CFP: 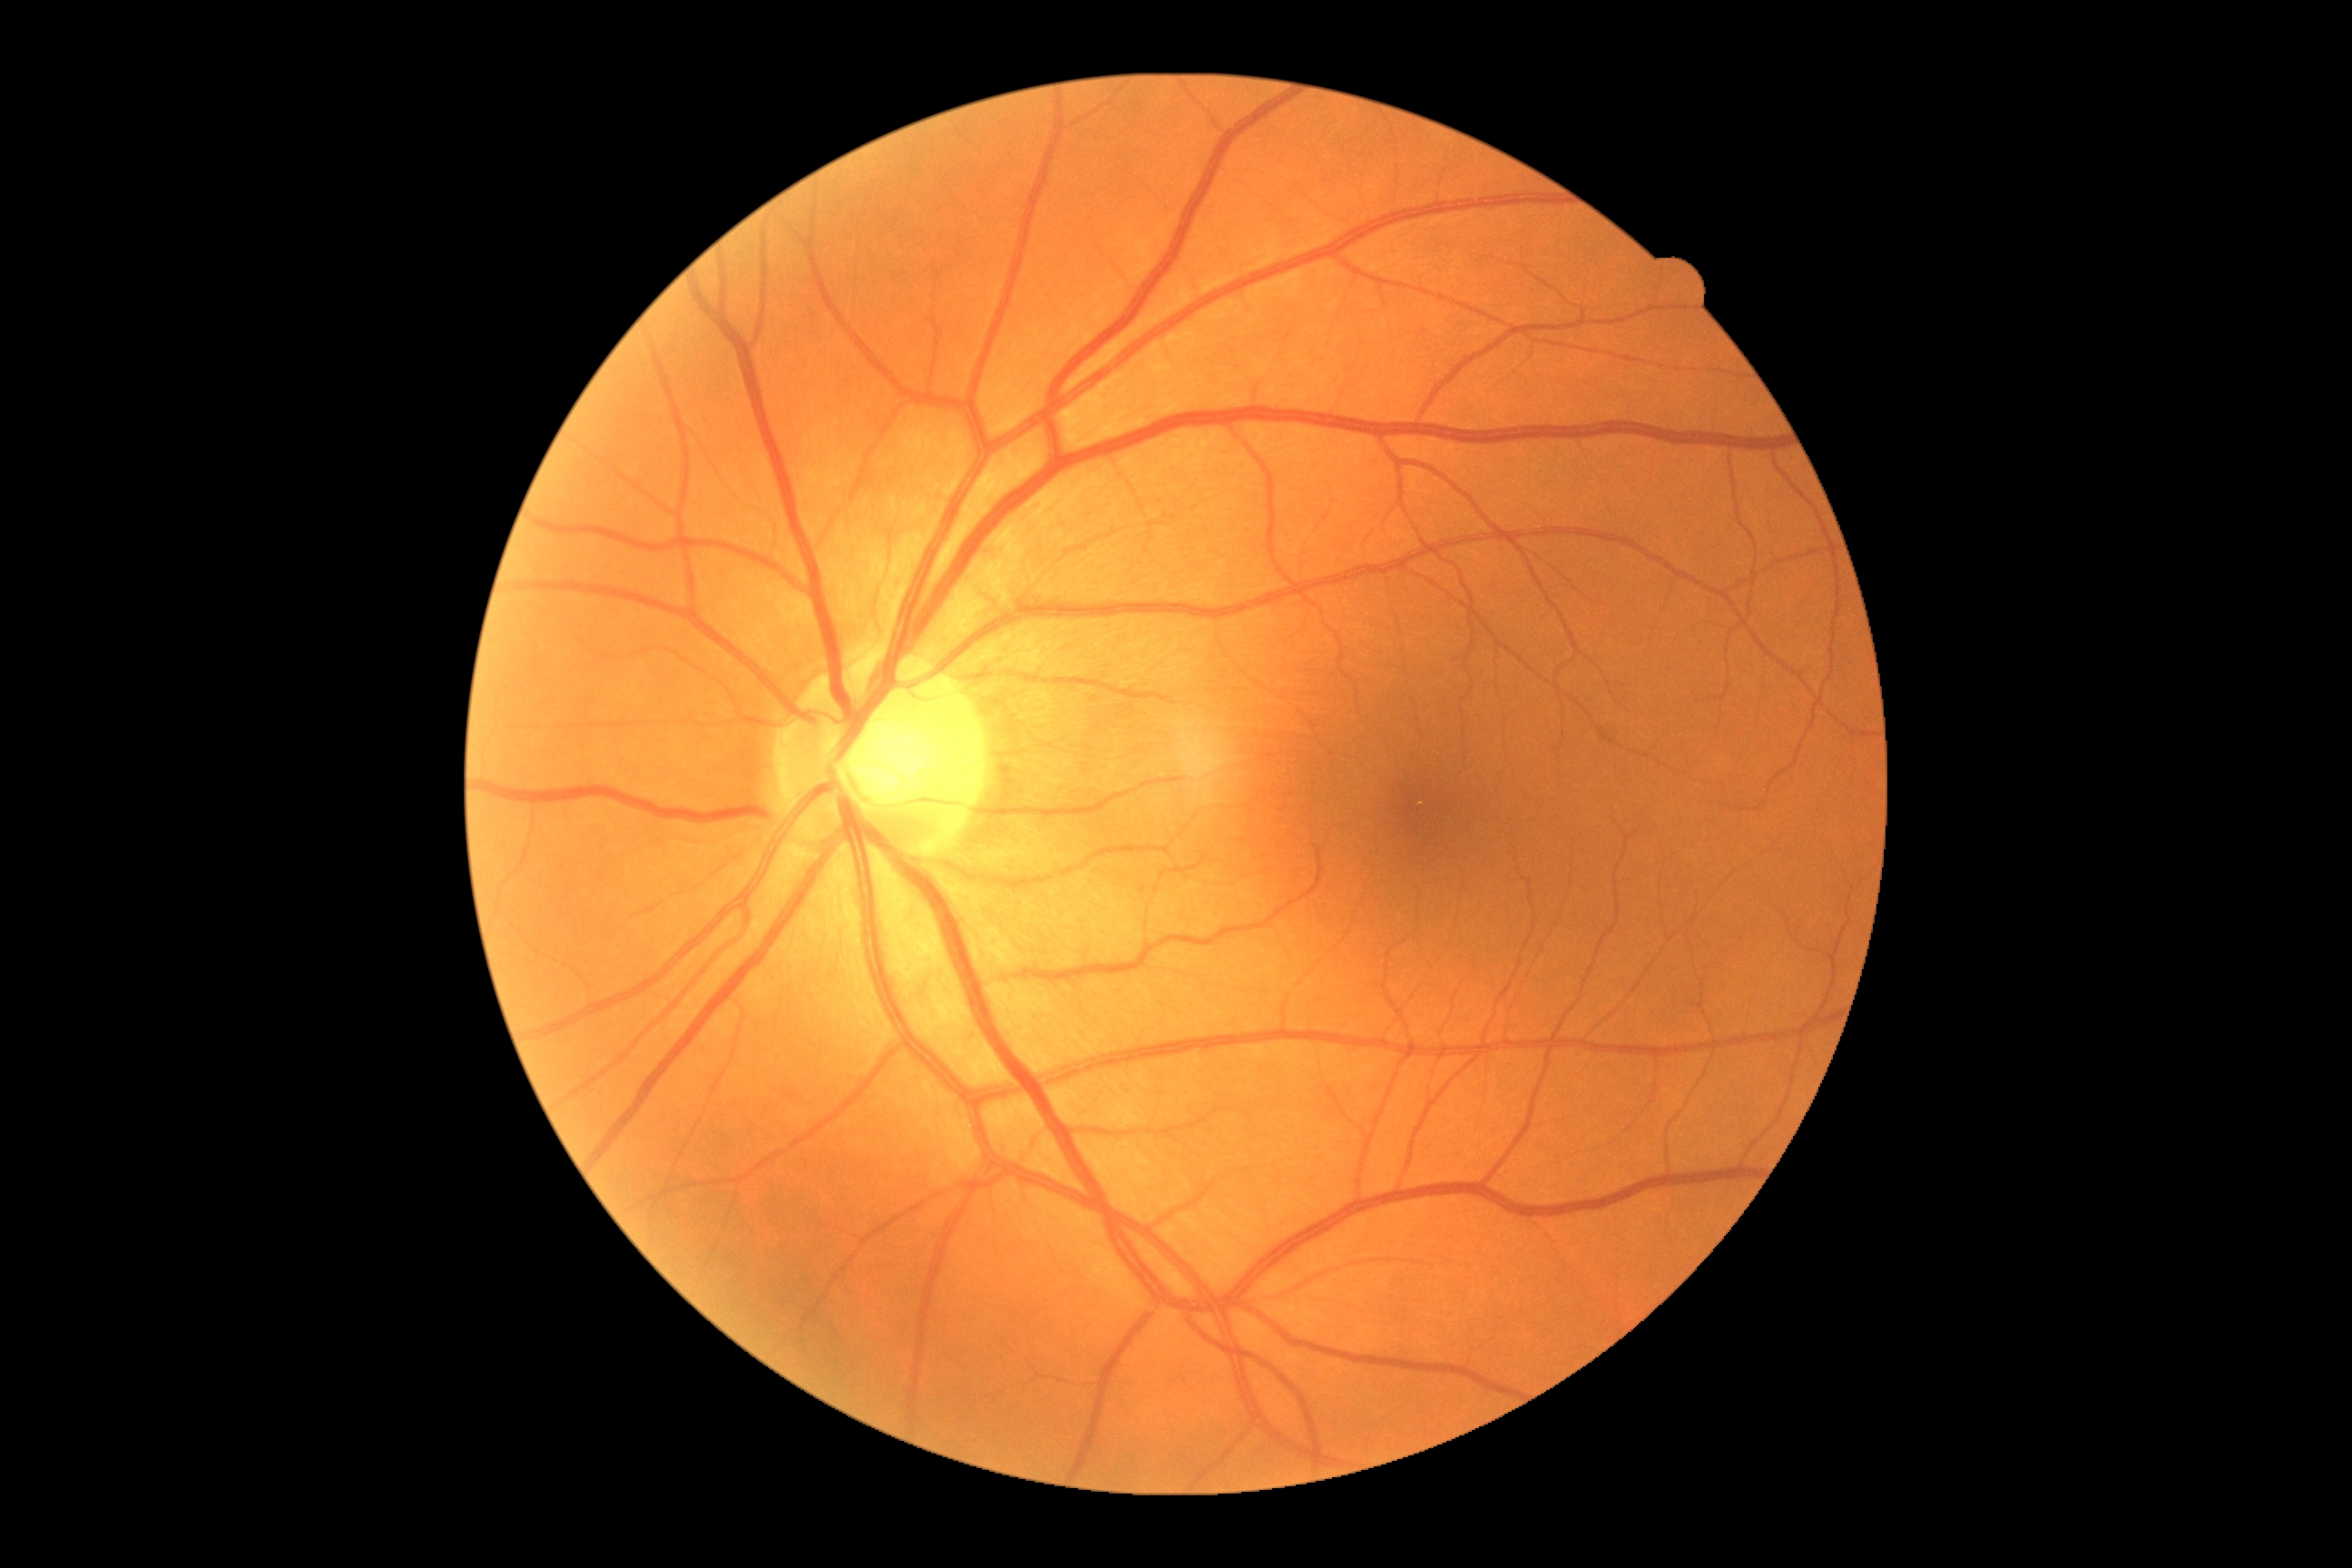

{
  "dr_grade": "0",
  "dr_impression": "no apparent DR"
}